1440 x 1080 pixels · infant wide-field fundus photograph
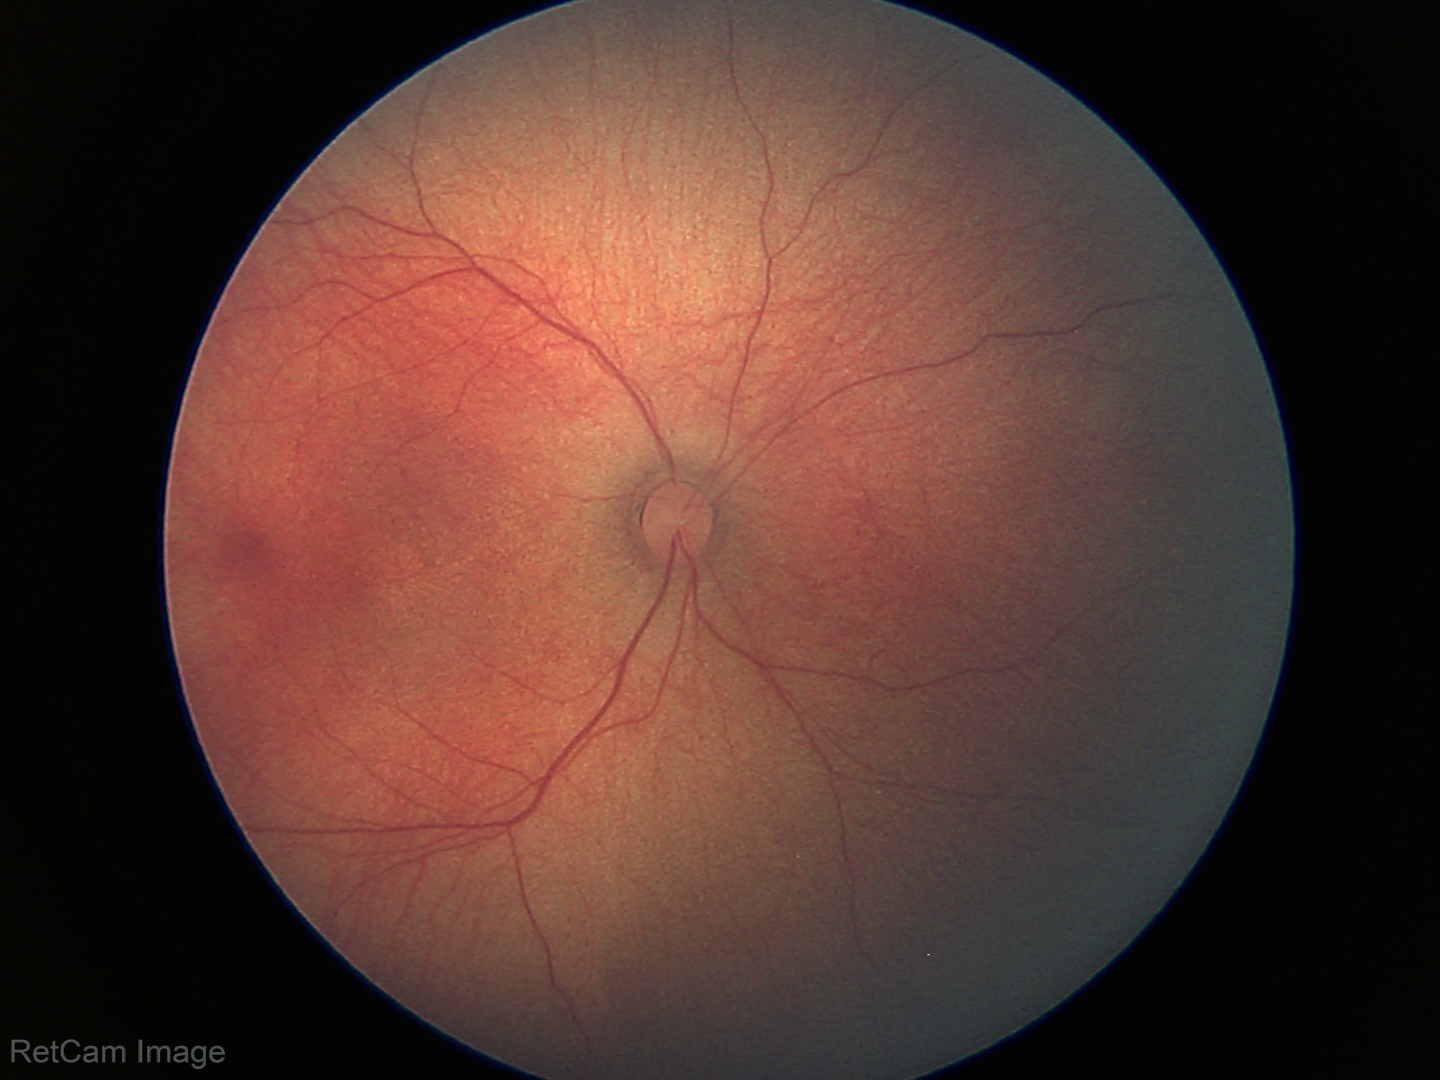 No retinal pathology identified on screening.